RetCam wide-field infant fundus image
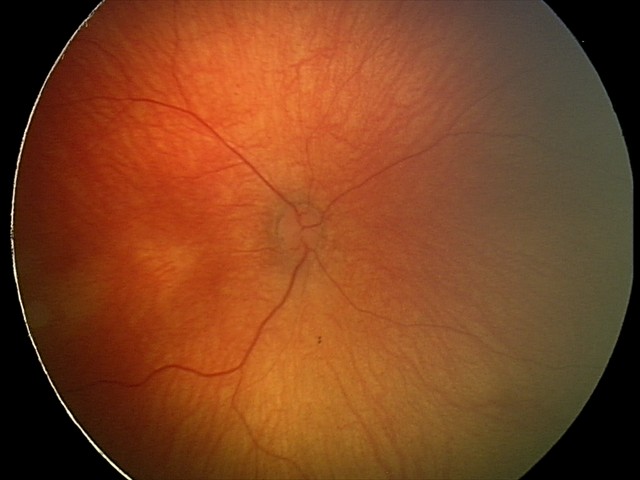
No retinal pathology identified on screening.